2352x1568px · Canon CR-1 — 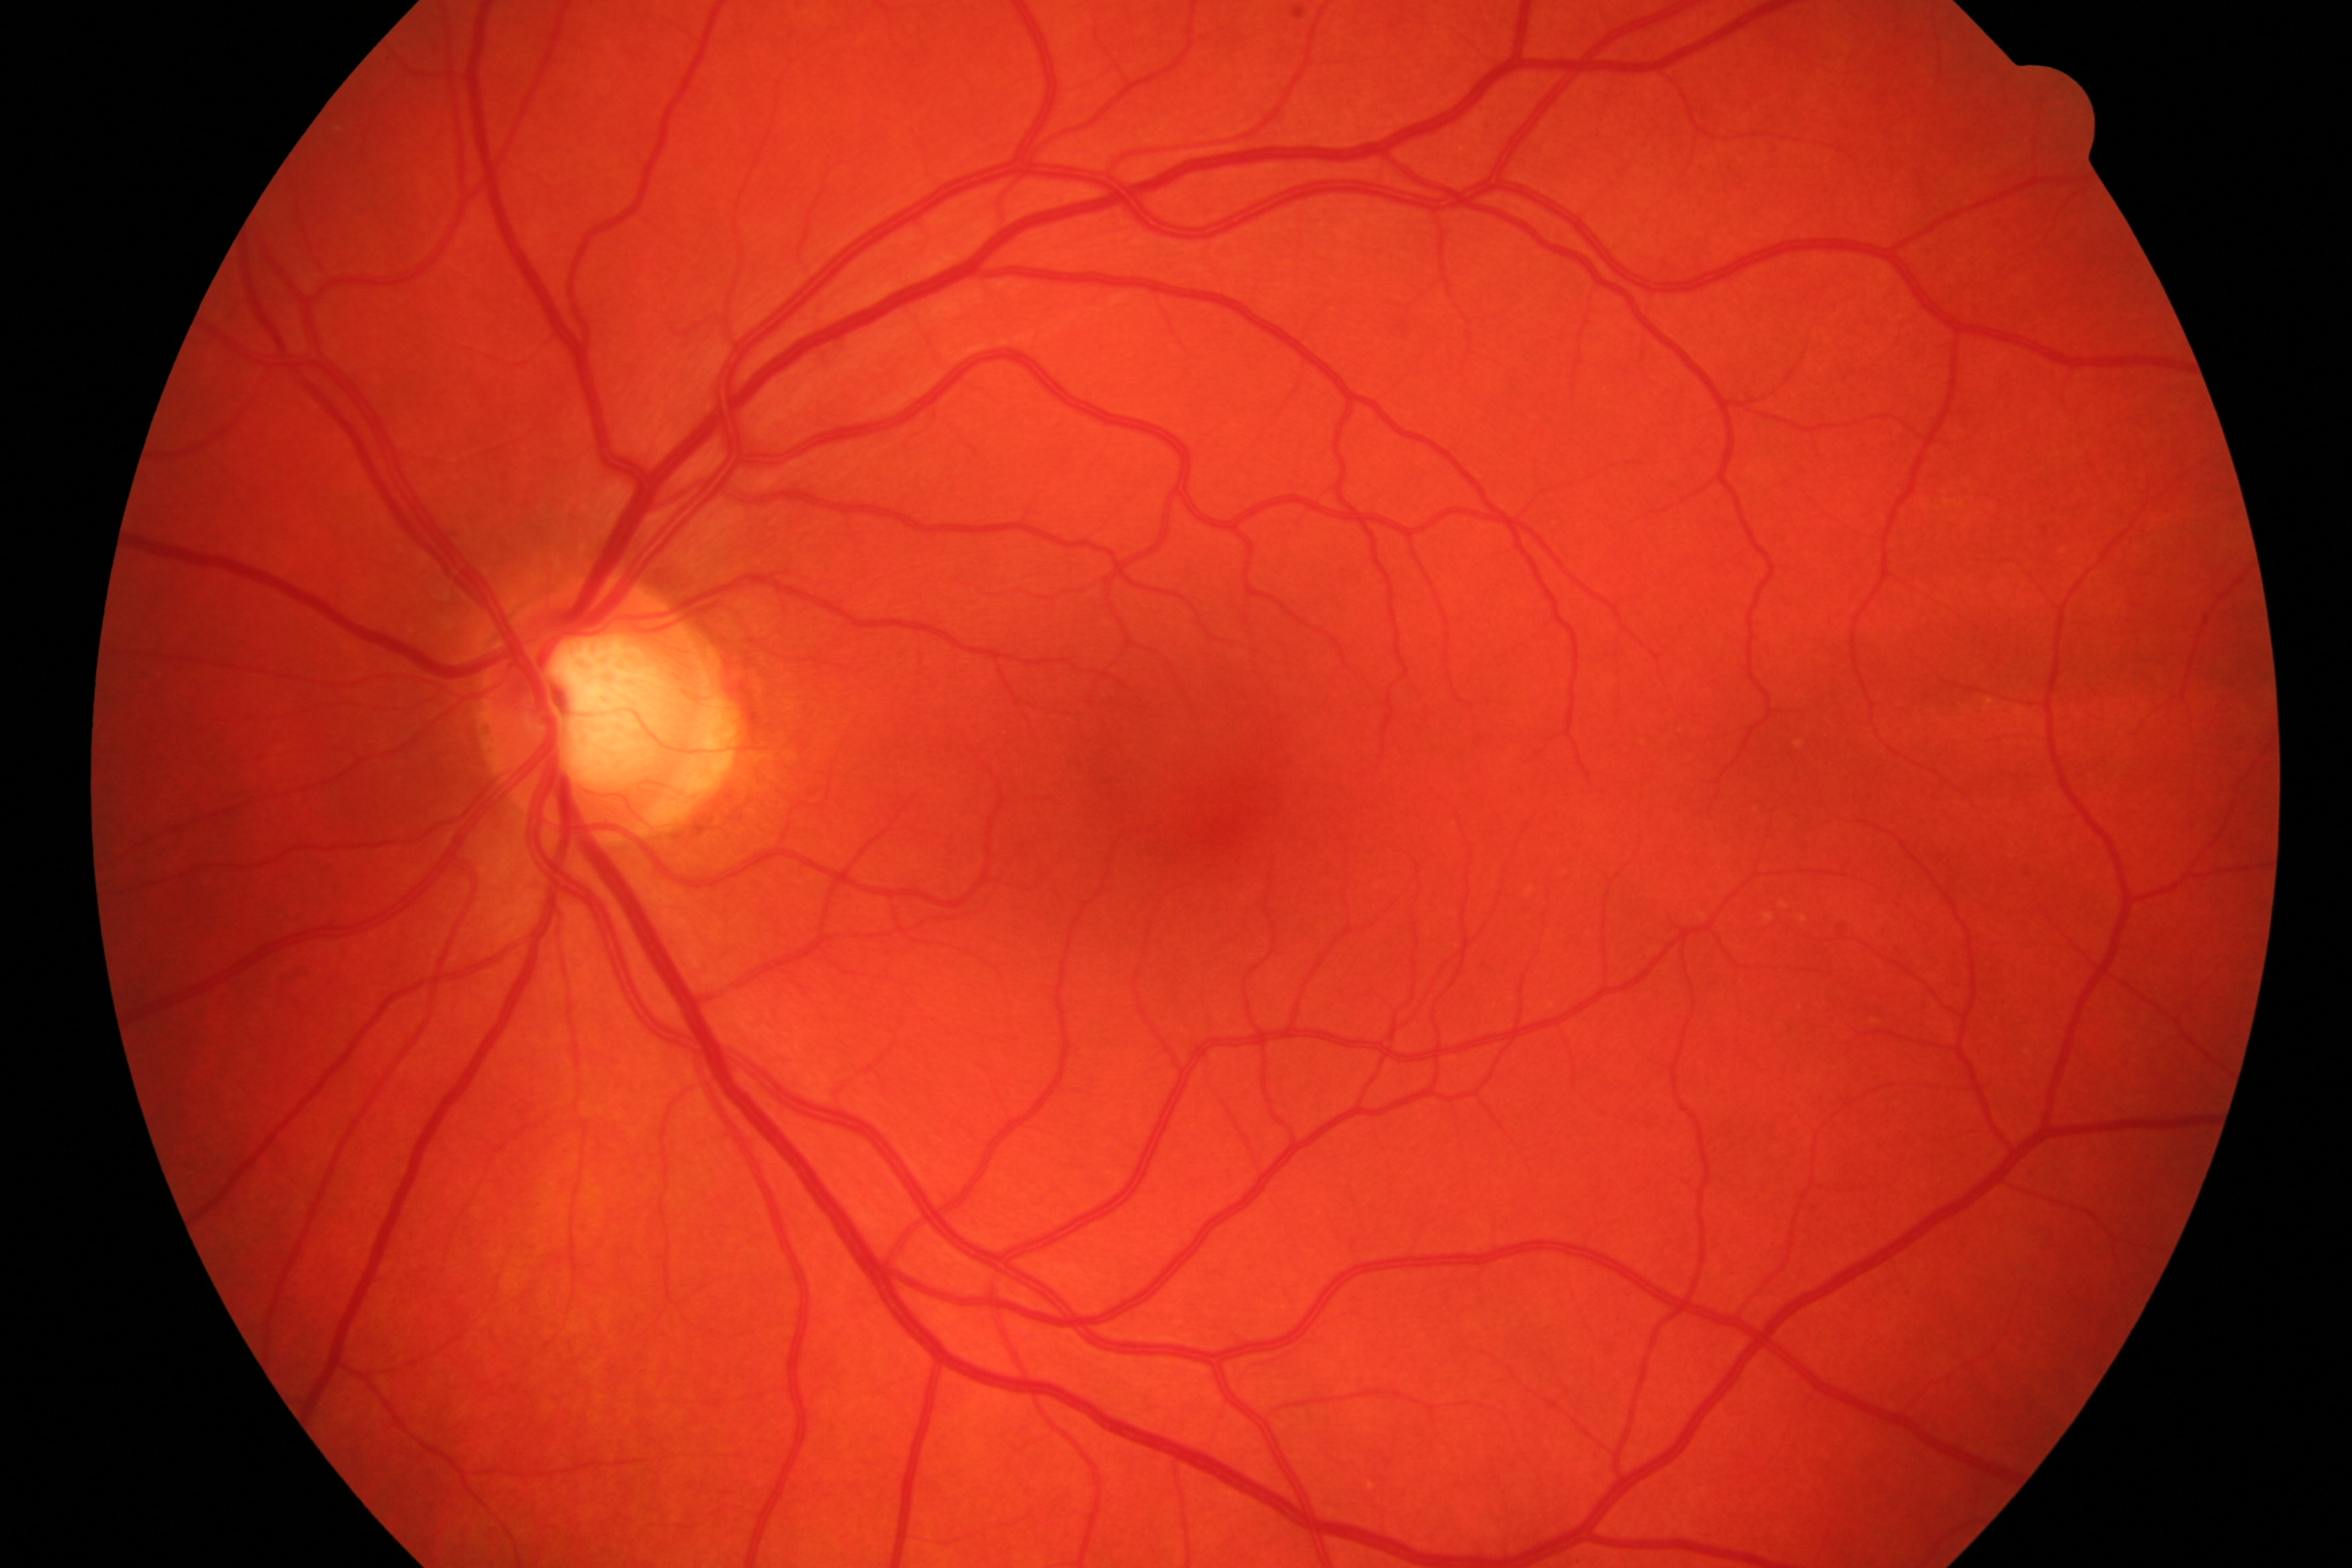 Impression: no DR or glaucoma.